Retinal fundus photograph, 45° FOV: 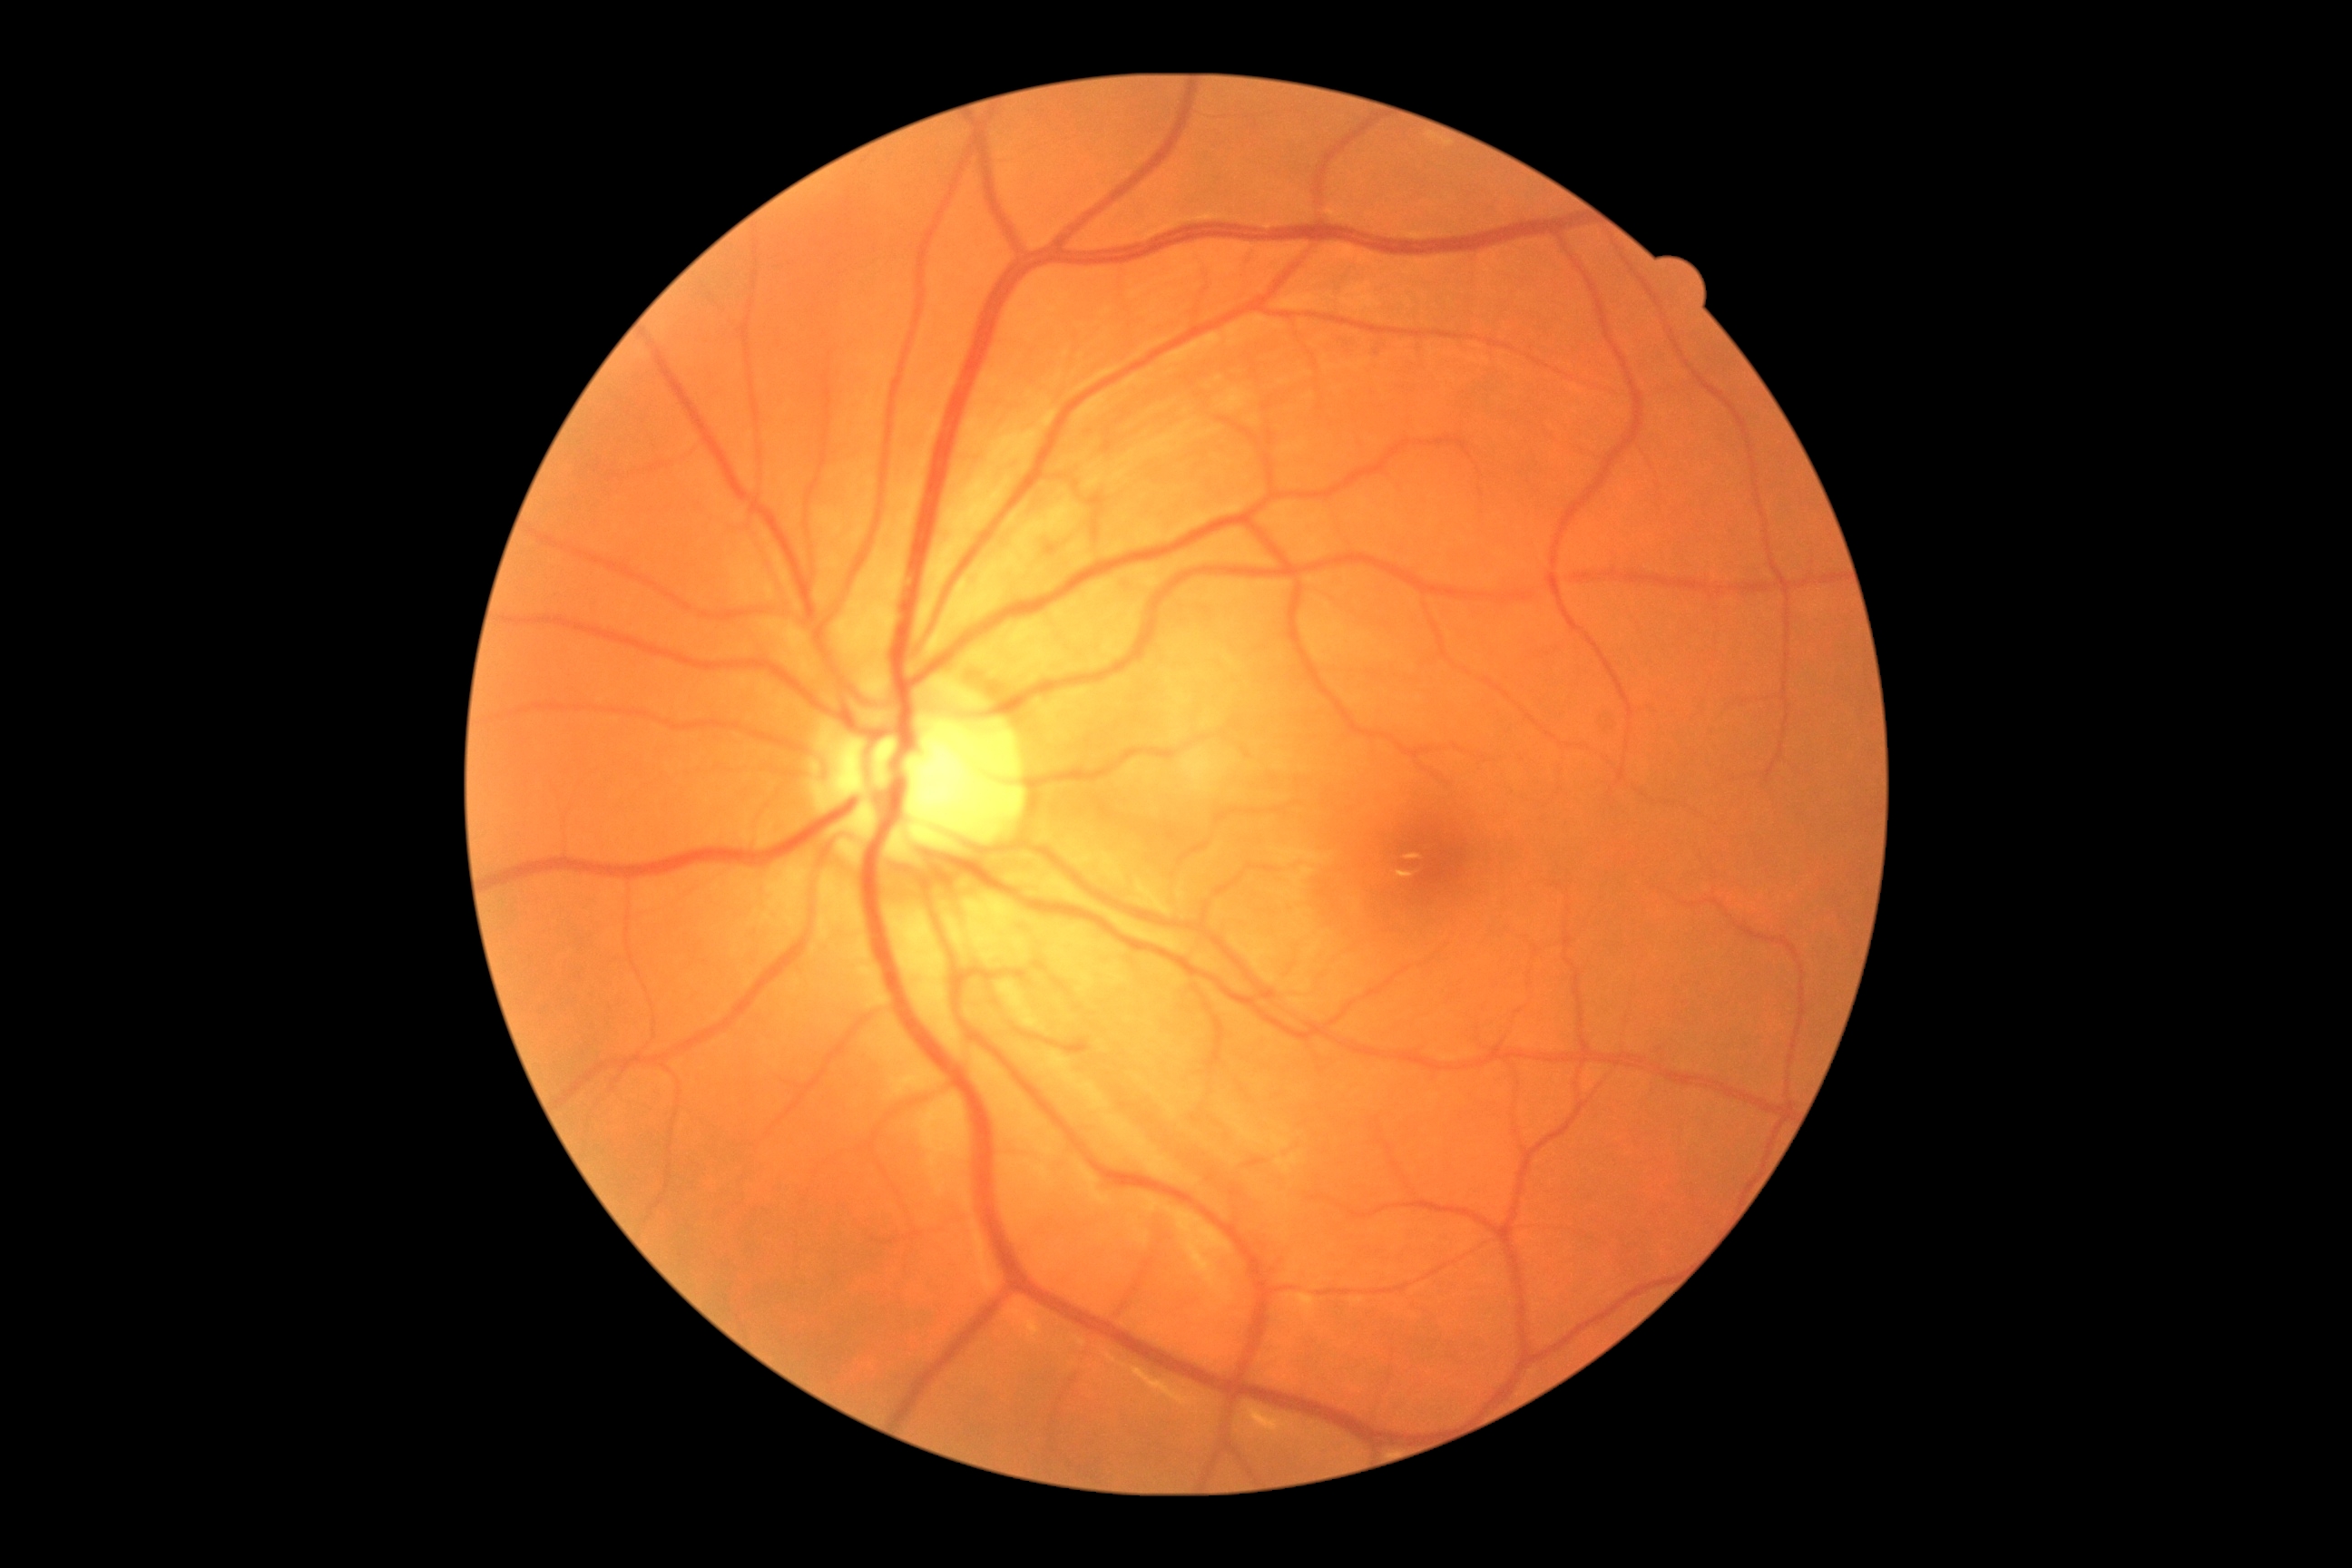

diabetic retinopathy (DR): grade 0.